Retinal fundus photograph — 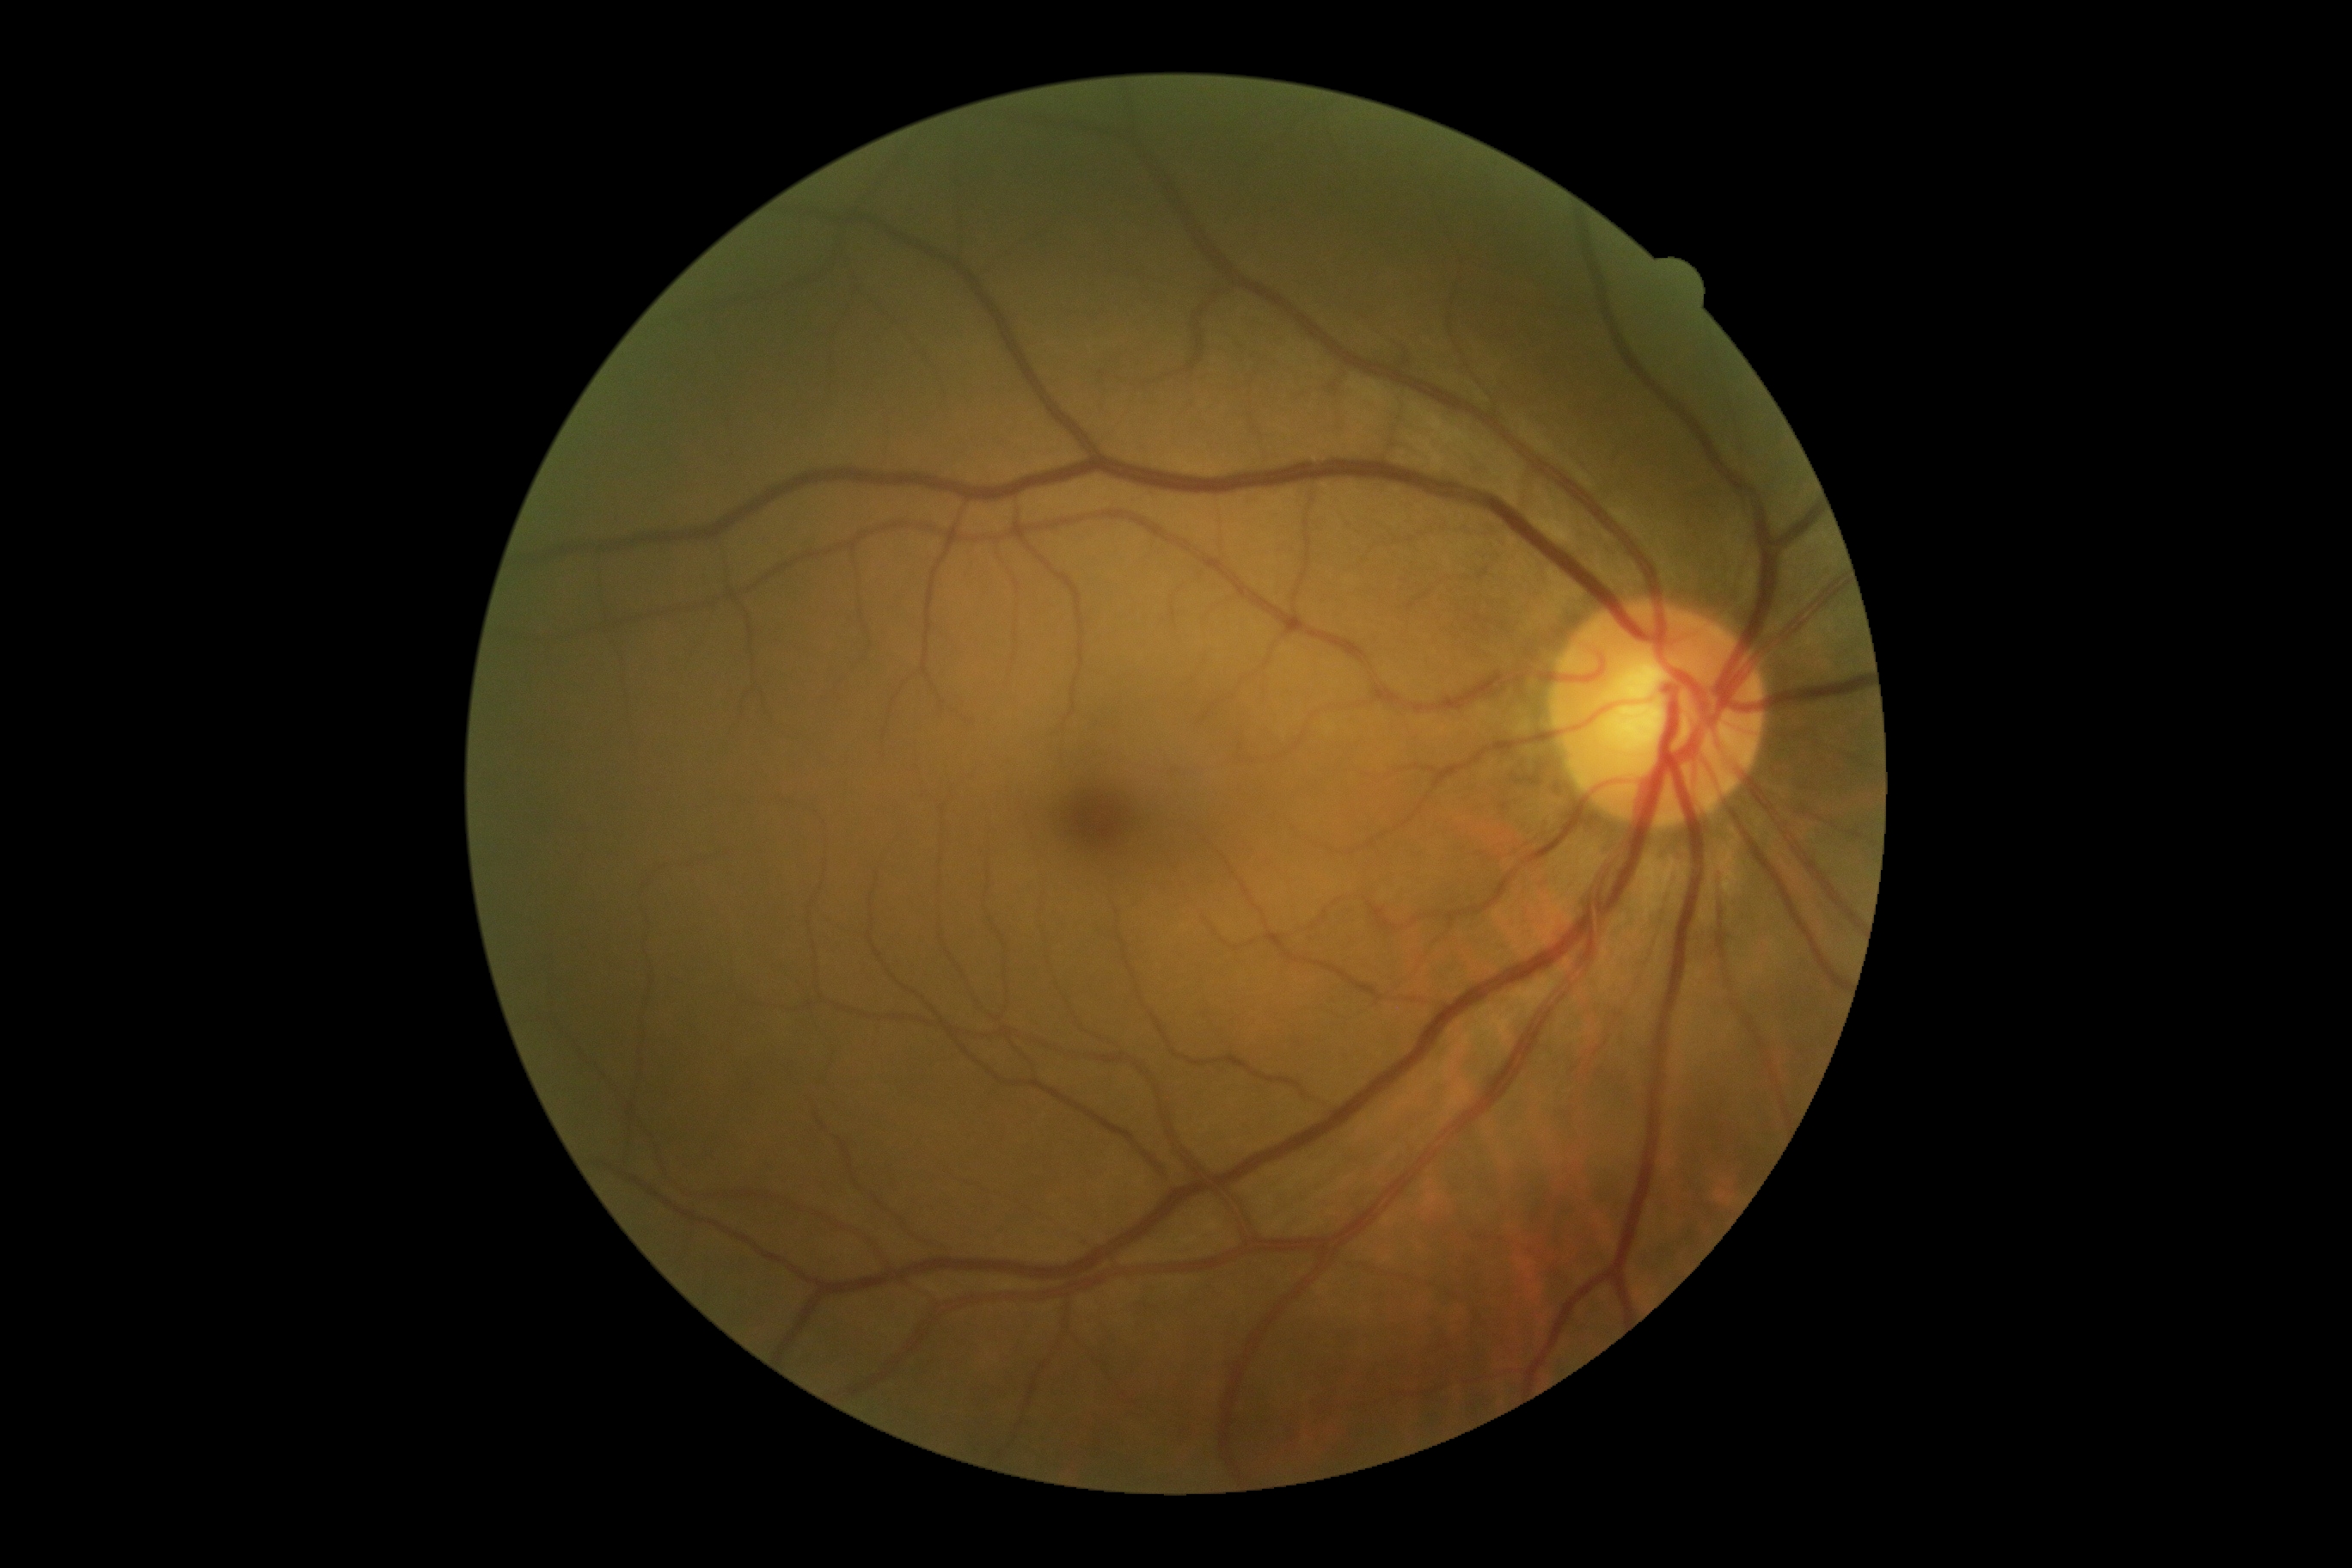
Annotations:
• DR grade: no apparent retinopathy (0)